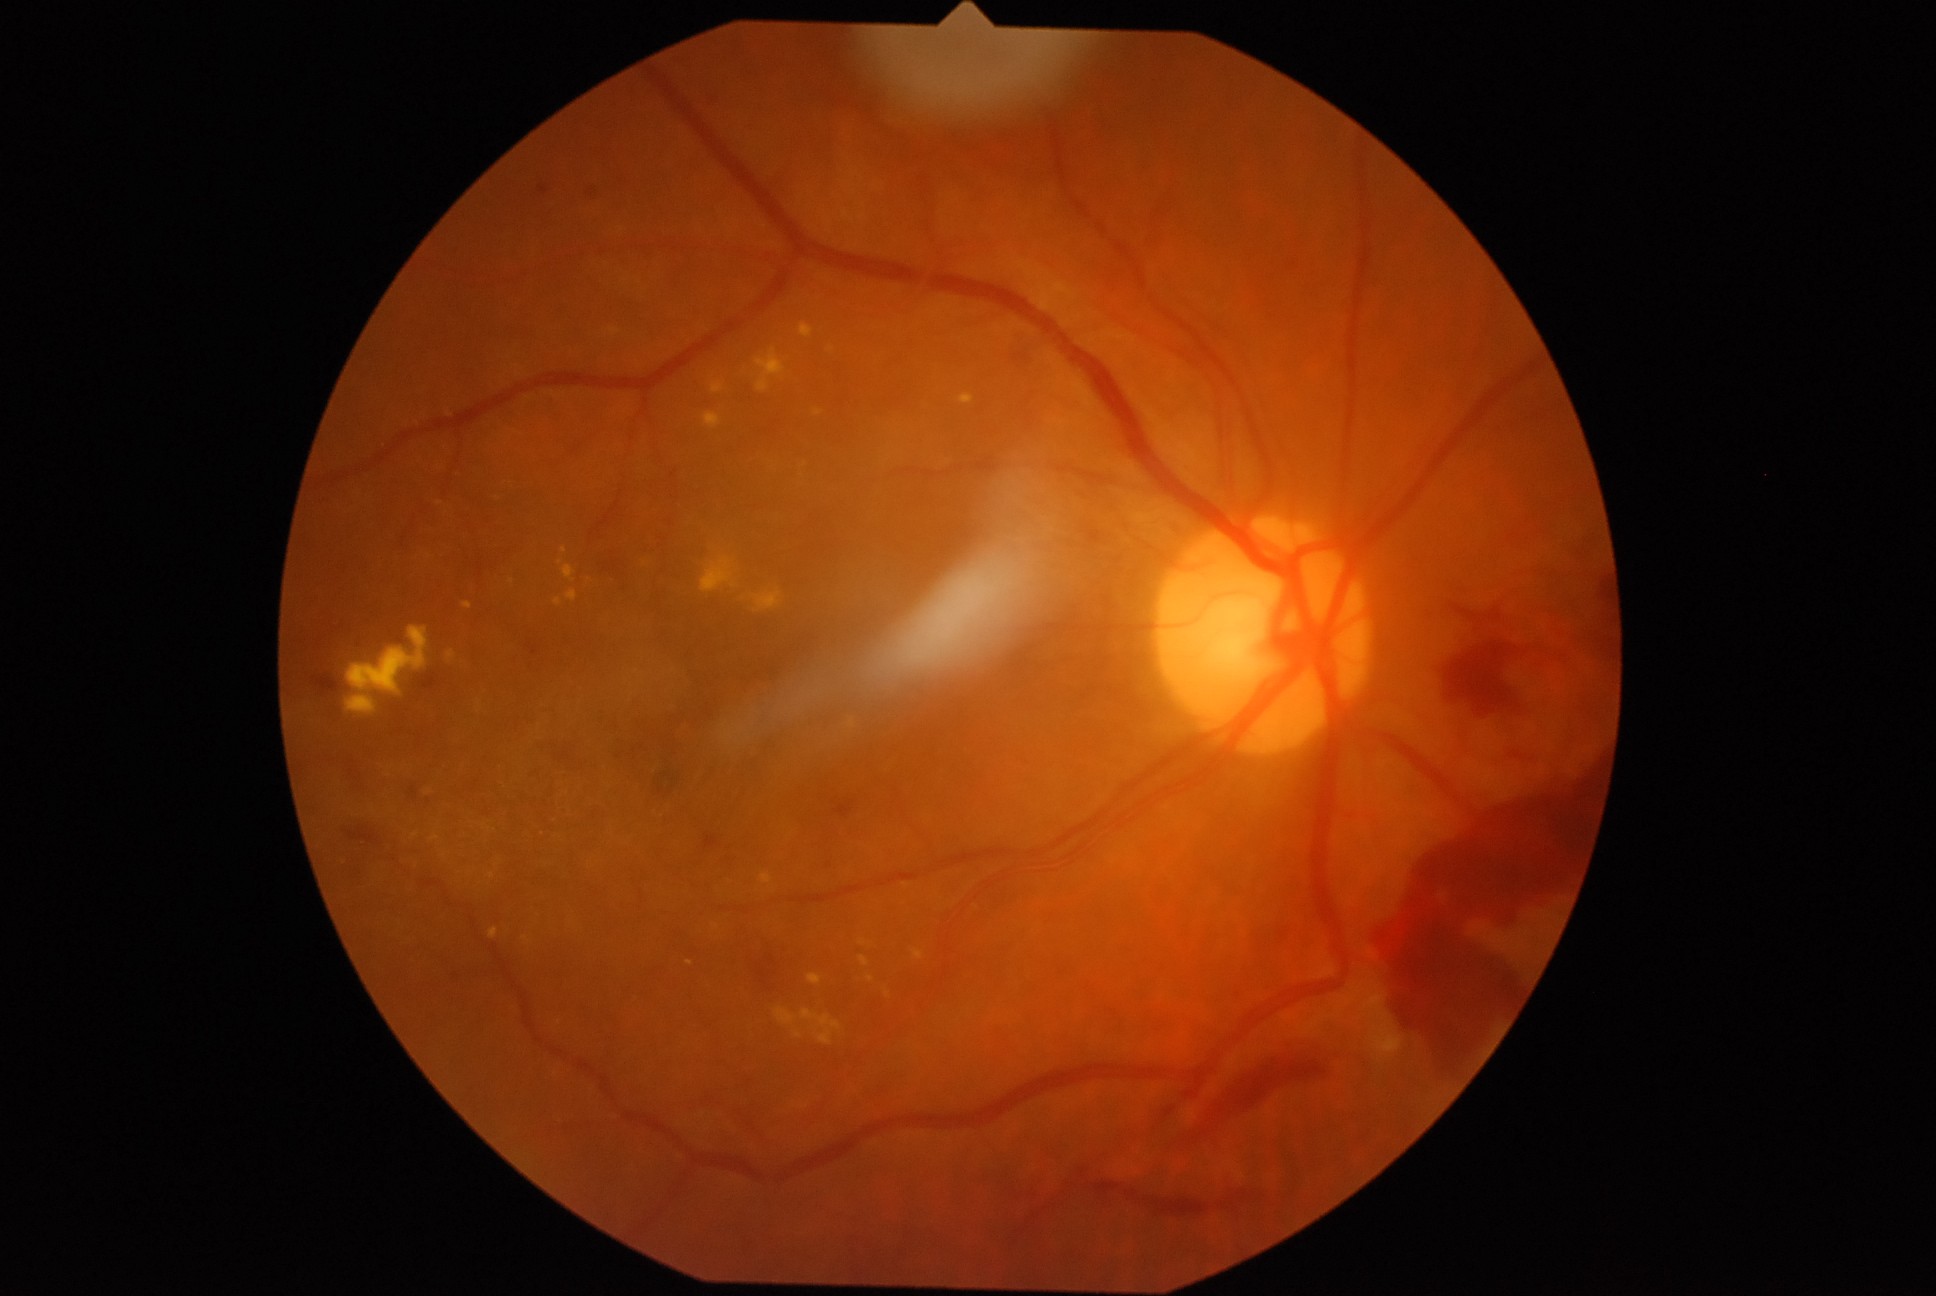

Retinopathy: 4/4 — neovascularization and/or vitreous/pre-retinal hemorrhage
Representative lesions:
hard exudates (partial): box(794, 1031, 802, 1039) | box(751, 589, 782, 614) | box(960, 394, 974, 405) | box(913, 950, 924, 961) | box(761, 874, 773, 884) | box(609, 328, 621, 336) | box(775, 1008, 798, 1026) | box(449, 652, 456, 660) | box(807, 975, 823, 986) | box(347, 627, 428, 695) | box(562, 566, 576, 583) | box(884, 989, 892, 999) | box(701, 557, 739, 594)
Hard exudates (small, approximate centers) near <pt>853,724</pt> | <pt>832,349</pt> | <pt>863,942</pt> | <pt>428,793</pt> | <pt>689,963</pt> | <pt>492,876</pt> | <pt>440,504</pt>
microaneurysms: none
soft exudates: none
hemorrhages (partial): box(647, 770, 676, 802) | box(581, 184, 597, 197) | box(1379, 757, 1607, 1085) | box(705, 836, 718, 850) | box(539, 186, 548, 194) | box(409, 786, 418, 802) | box(312, 674, 339, 696) | box(596, 550, 622, 575) | box(754, 939, 784, 991) | box(420, 674, 439, 691) | box(529, 644, 538, 656) | box(1095, 1183, 1122, 1196) | box(1445, 640, 1520, 717)